Posterior pole view, camera: Topcon TRC-50DX.
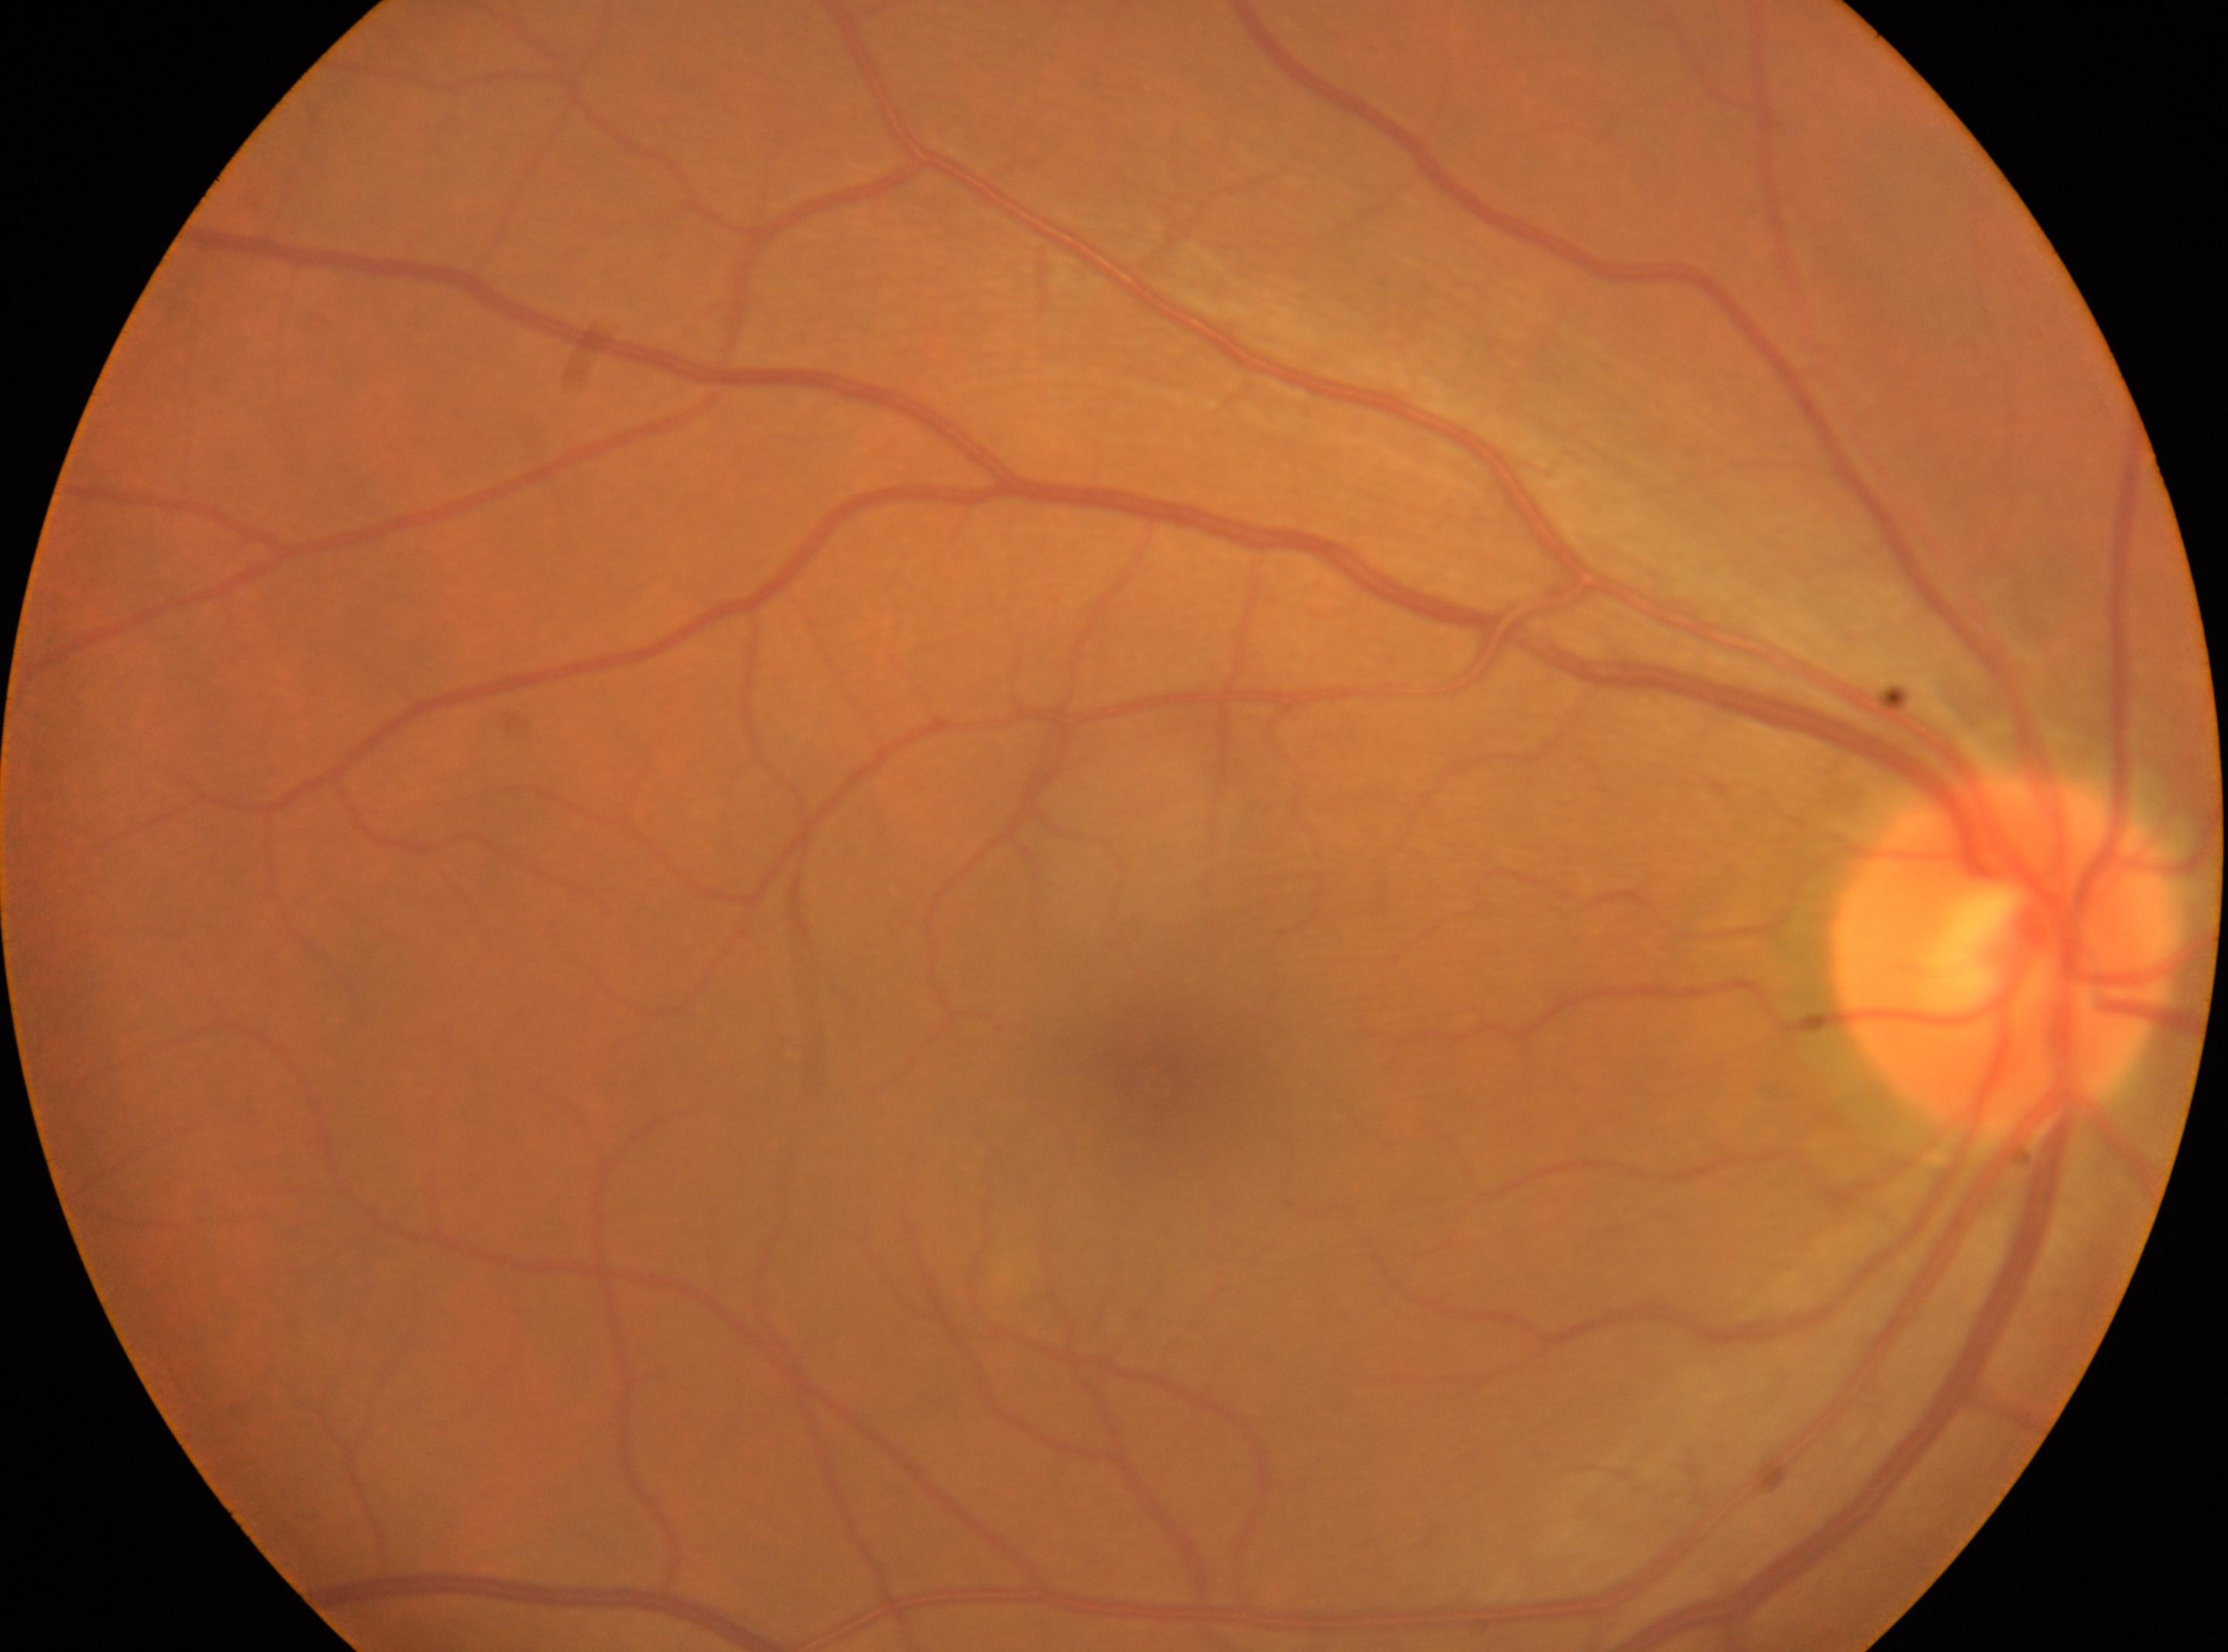

This is the right eye. Retinopathy grade is 0. Macula center: 1157px, 1081px. The optic disc center is at 2002px, 959px.